Central corneal thickness: 543 µm; visual field mean defect (MD): -12.52 dB; age 78; female patient; refractive error: +1.5 -2.25 x 90; intraocular pressure (IOP): 16 mmHg
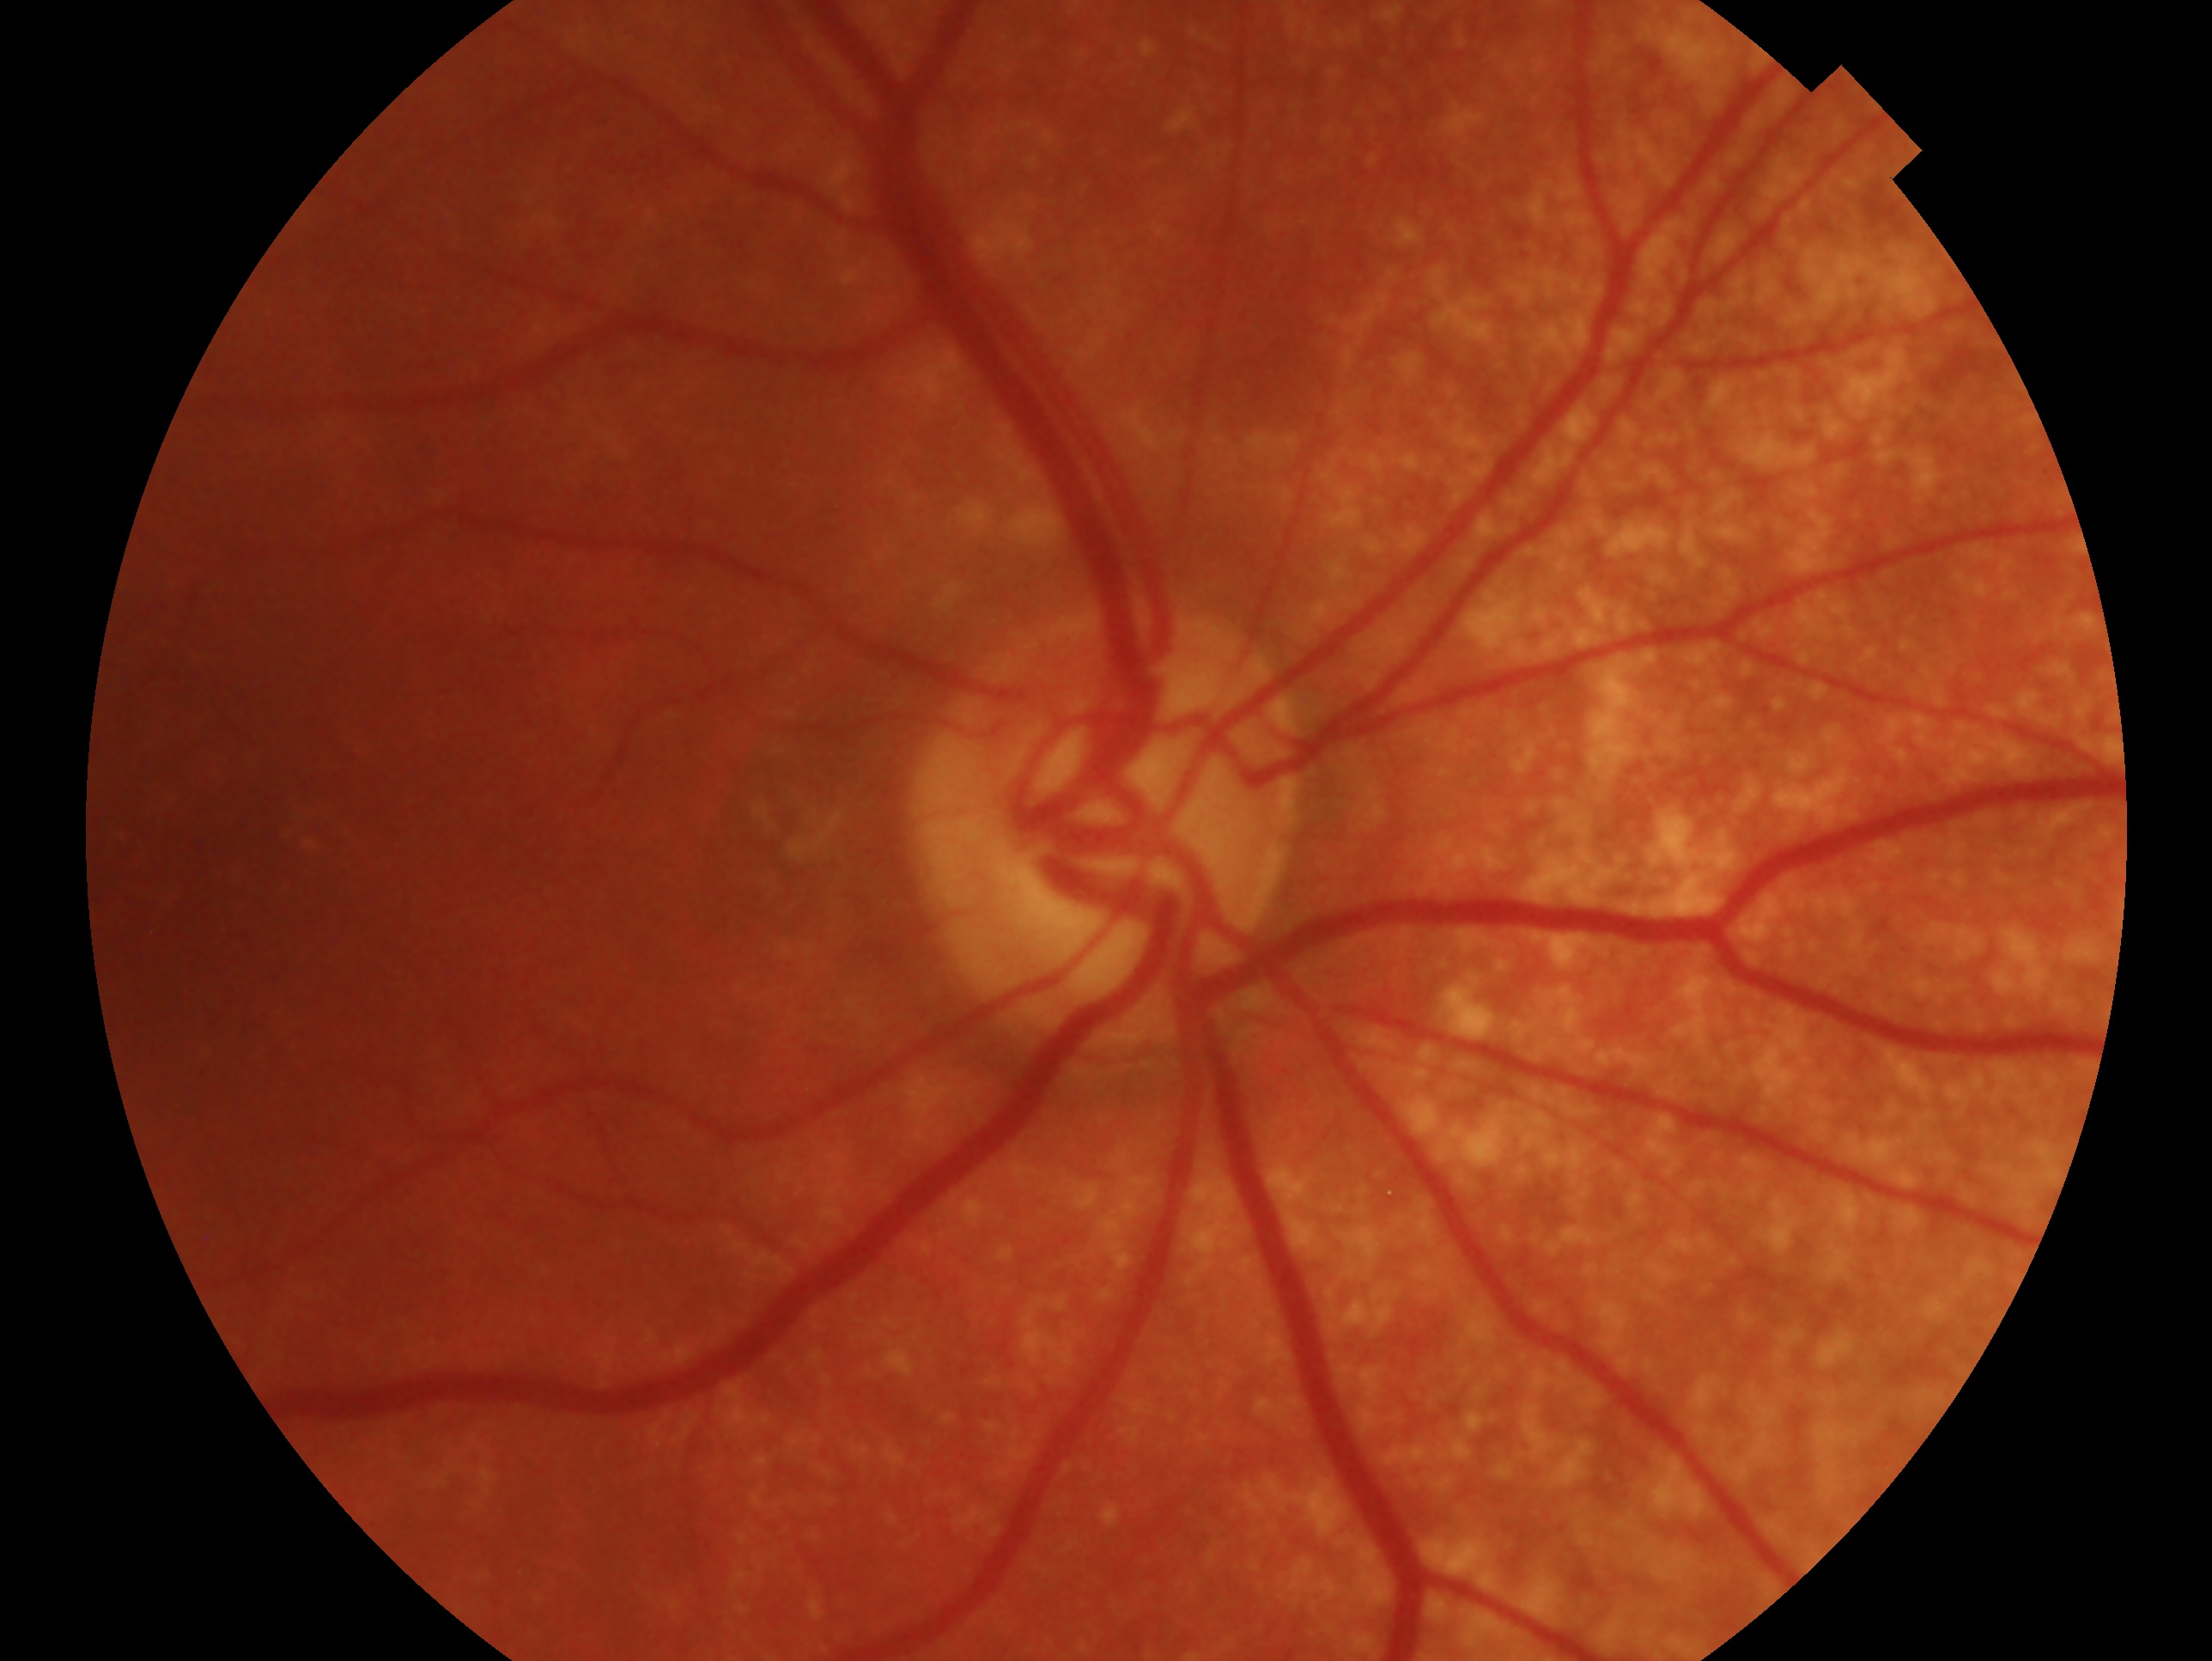 Glaucoma diagnosis — glaucoma.
Imaged eye: OD.